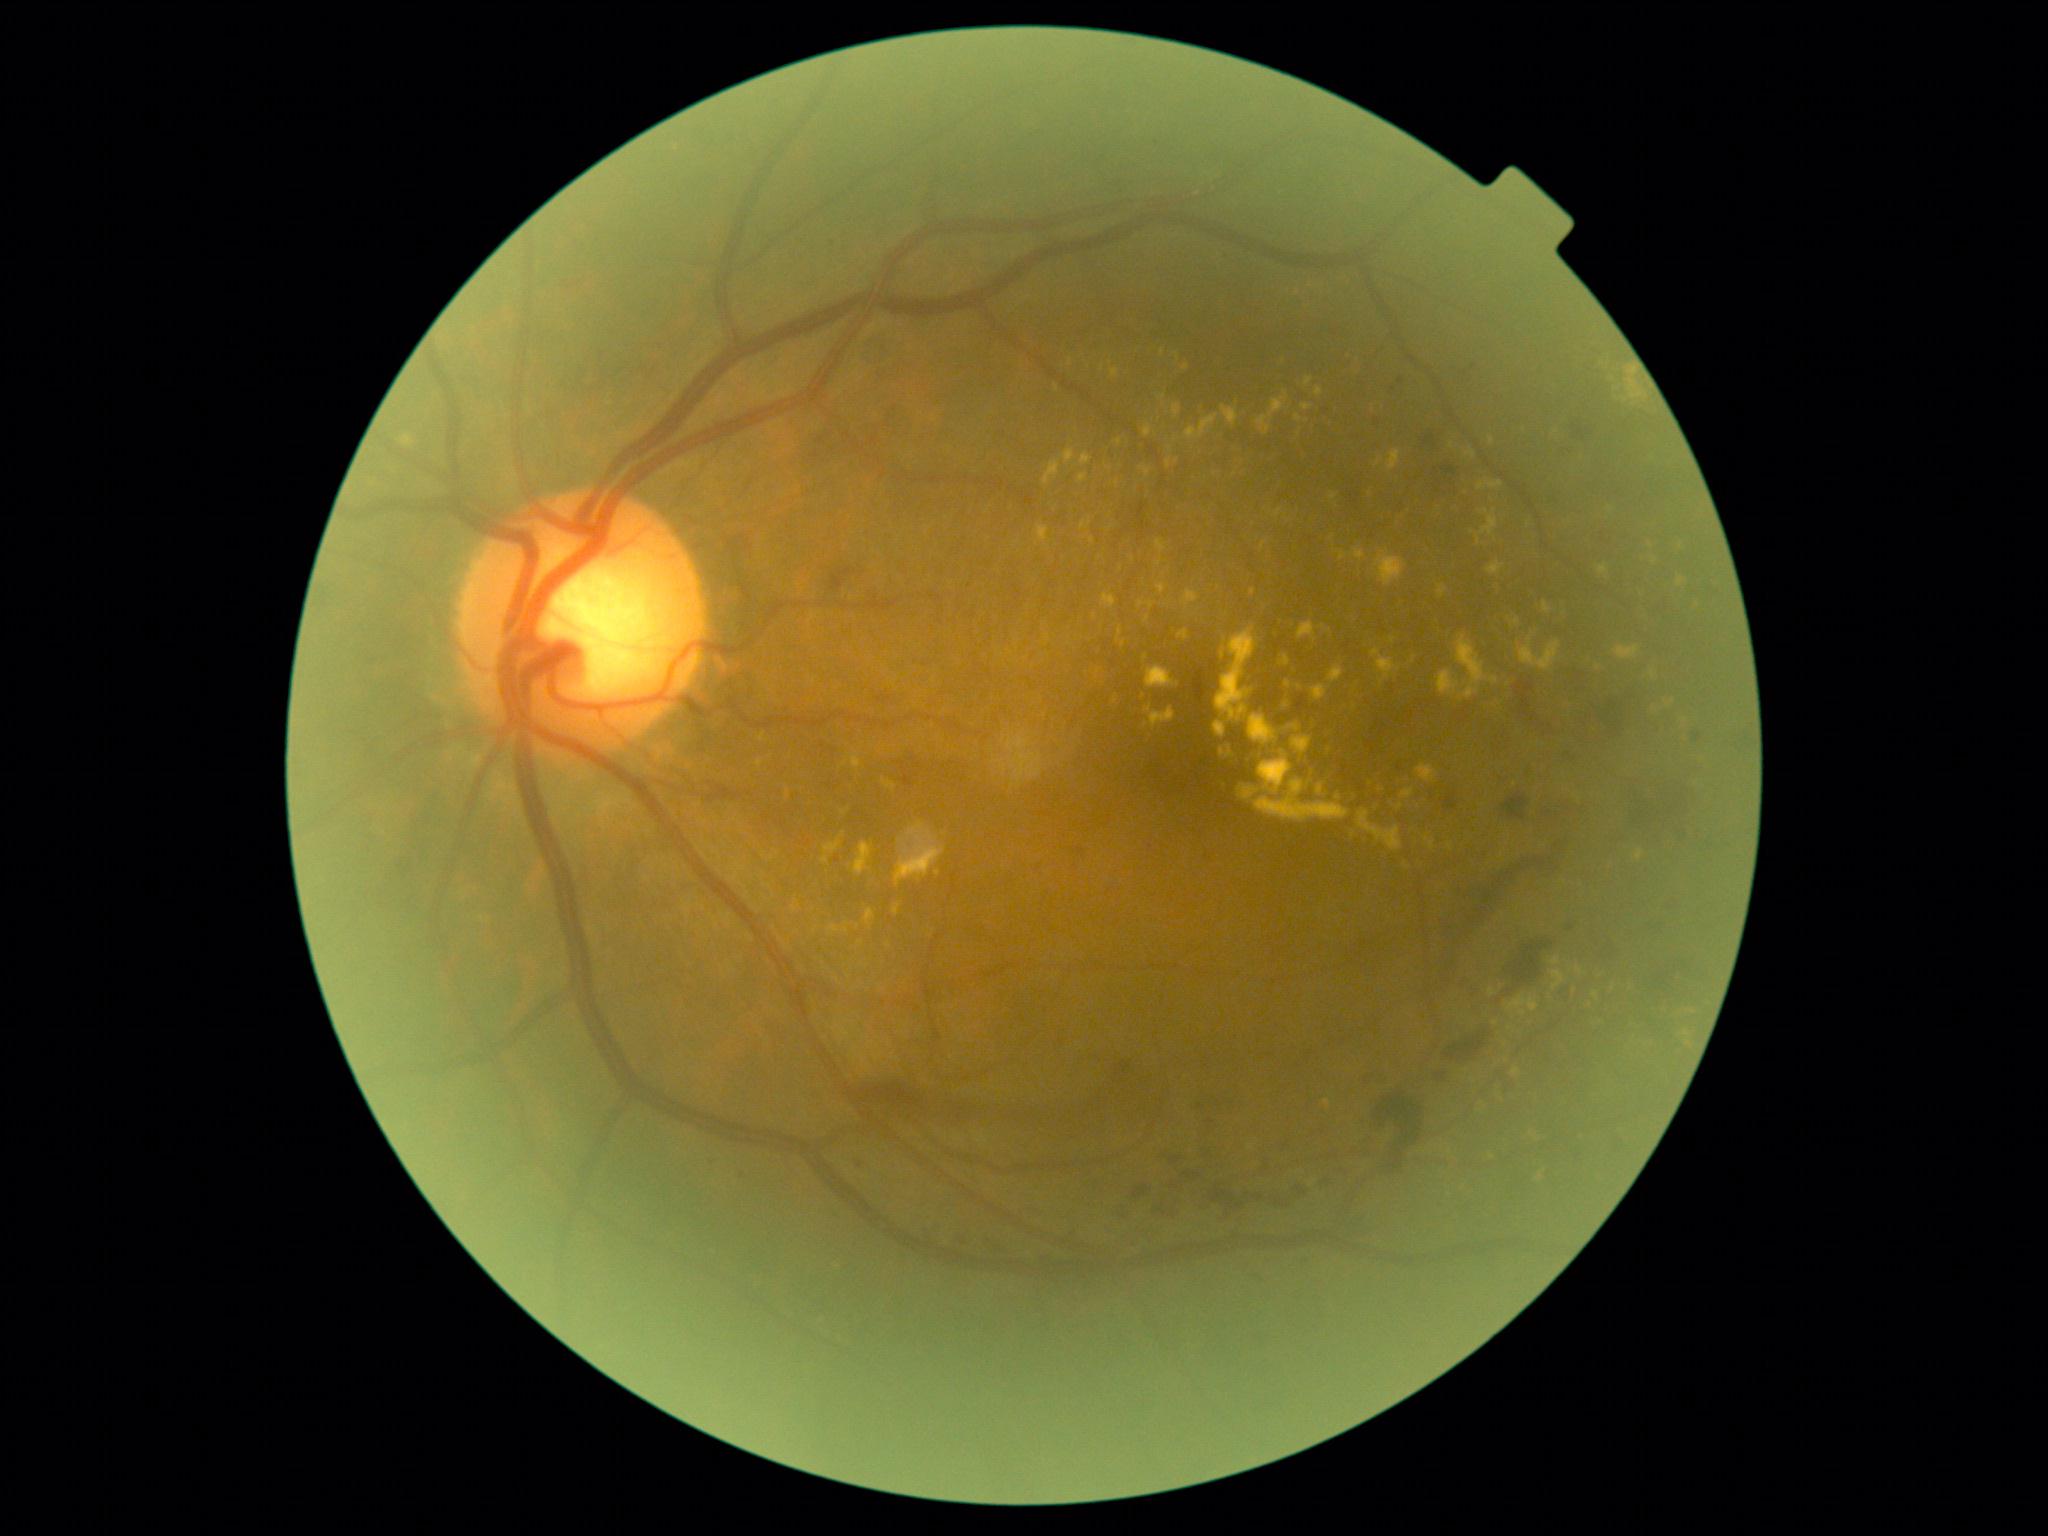 Diabetic retinopathy: grade 2 (moderate NPDR)
Representative lesions:
hard exudates (more not shown): (1513,1068,1521,1076); (1550,958,1560,967); (1038,526,1049,542); (1492,1021,1500,1027); (1240,786,1260,800); (1371,649,1401,679); (1290,724,1302,733); (1043,461,1061,486); (1302,405,1313,412); (1597,564,1609,575); (1219,748,1225,757); (1217,627,1277,746)
Small hard exudates near (772, 859); (938, 874); (1123, 644); (1146, 725); (1414, 660); (858, 927); (1473, 533)
hemorrhages (more not shown): (860,1083,921,1109); (1442,467,1456,475); (1442,793,1459,811); (970,1237,1009,1254); (1628,779,1687,842); (877,695,892,704); (1501,792,1529,821); (1608,938,1621,962); (1598,699,1622,738); (1423,435,1437,448); (1110,1206,1127,1222); (831,568,852,591); (1436,1073,1446,1082); (1253,1195,1264,1202); (1513,683,1540,731); (1439,837,1572,987); (1295,1186,1307,1196); (1508,1076,1521,1094)
Small microaneurysms near (1394, 390); (1211, 1122); (1401, 382); (1474, 367); (1326, 412); (1201, 1107); (860, 1166); (1081, 851); (838, 861); (742, 1176)
soft exudates: none detected